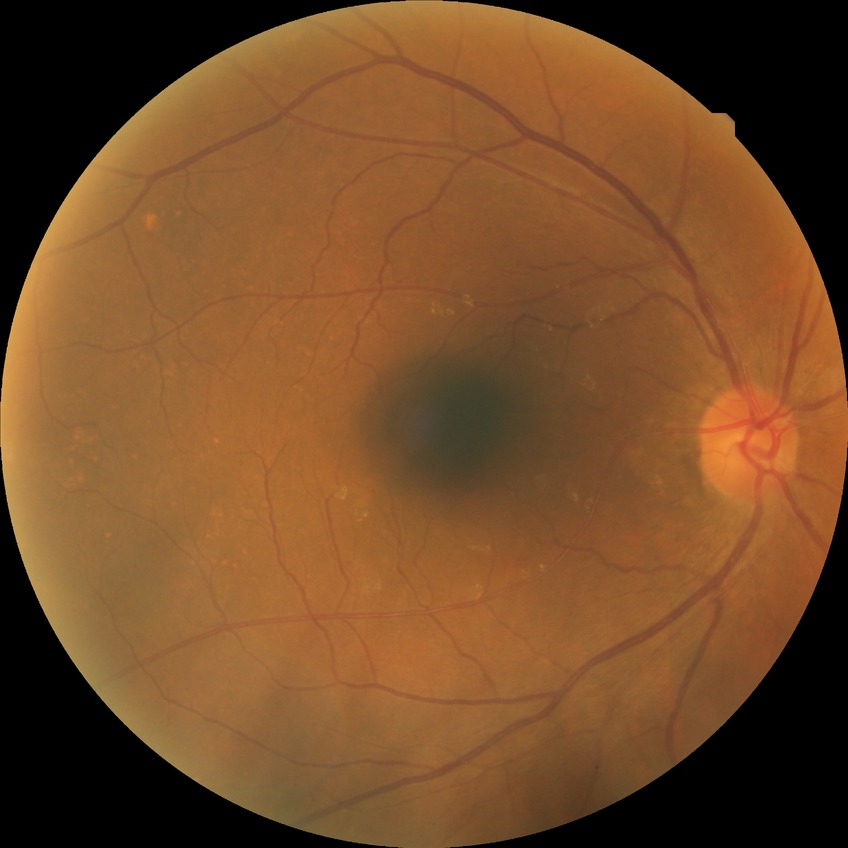
Diabetic retinopathy stage is no diabetic retinopathy.